130° field of view (Clarity RetCam 3) · wide-field contact fundus photograph of an infant — 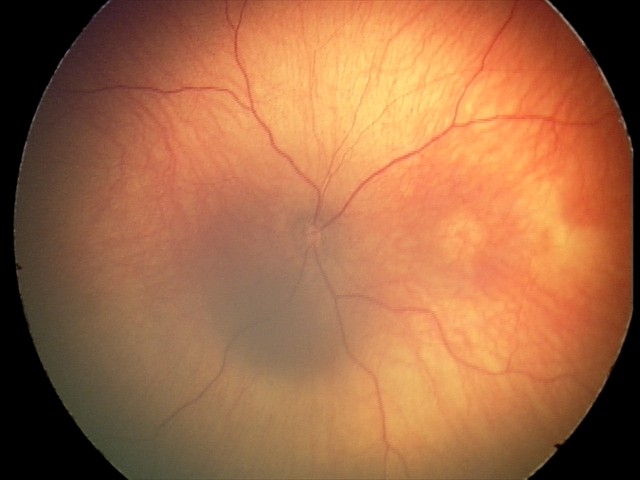

Assessment = no pathology identified